Graded on the modified Davis scale.
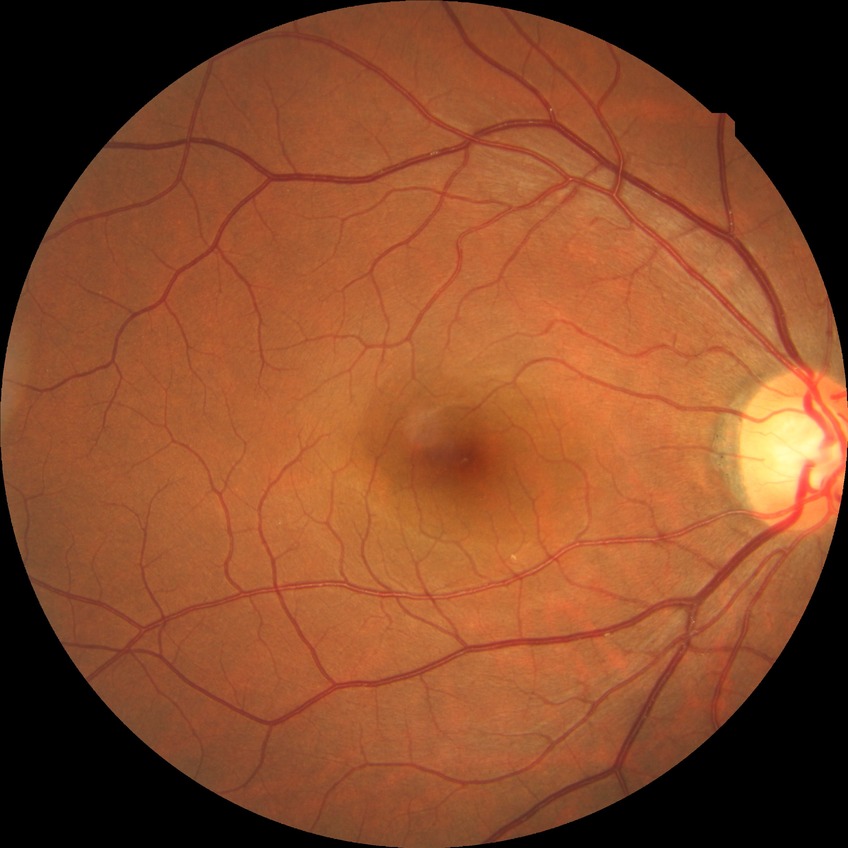

Diabetic retinopathy (DR): NDR (no diabetic retinopathy).